Modified Davis grading; camera: NIDEK AFC-230; 848 by 848 pixels; nonmydriatic fundus photograph
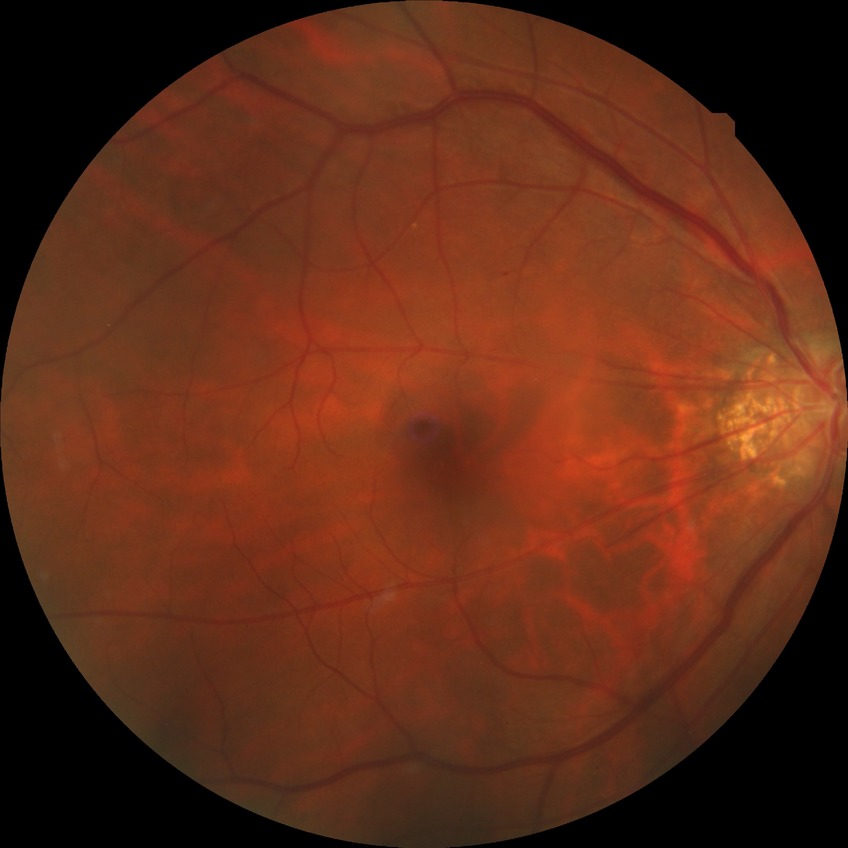
Davis grading: no diabetic retinopathy.